NIDEK AFC-230. Graded on the modified Davis scale: 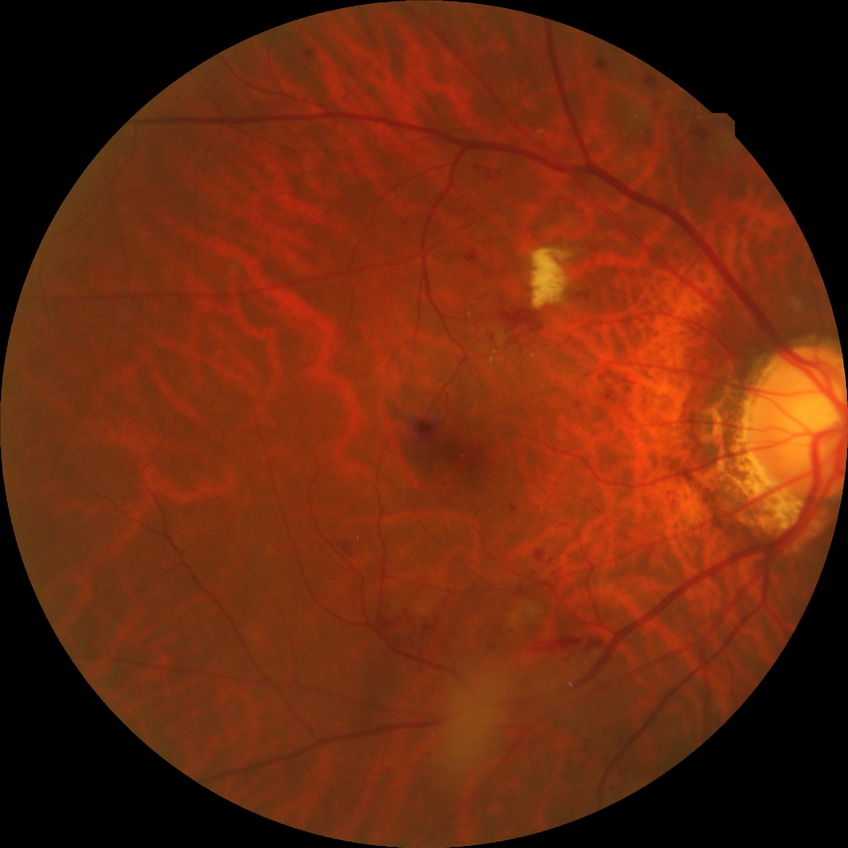 {"davis_grade": "pre-proliferative diabetic retinopathy", "proliferative_class": "non-proliferative diabetic retinopathy"}